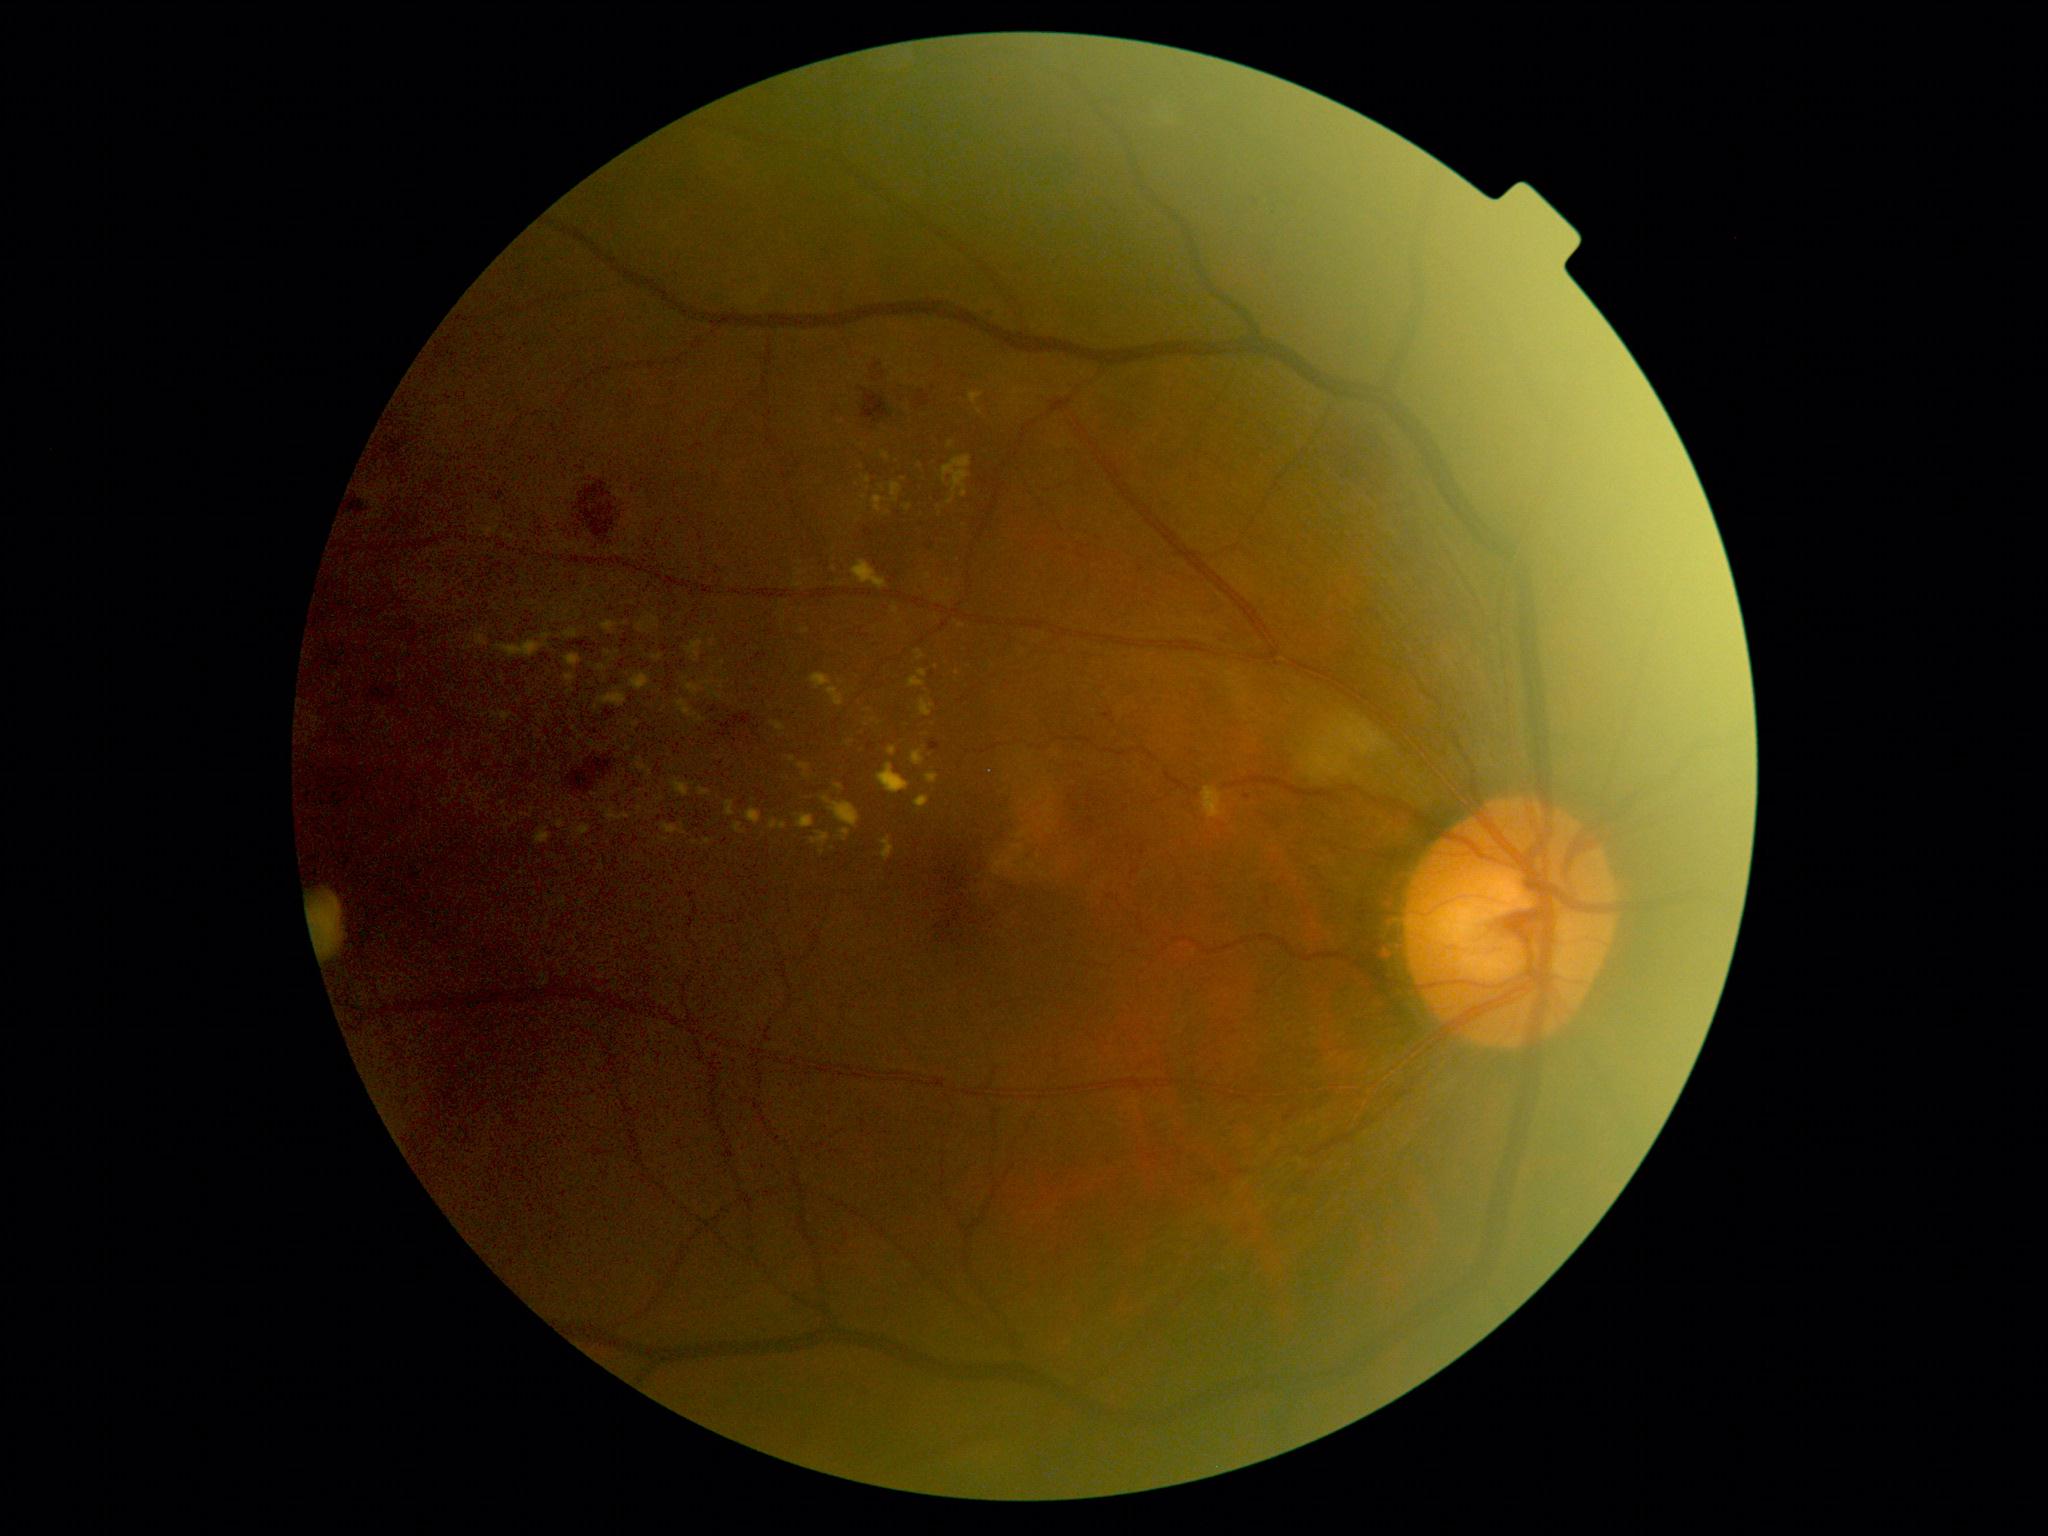 Diabetic retinopathy (DR): moderate non-proliferative diabetic retinopathy (grade 2)
Lesions identified (partial list):
hard exudates (EXs) (continued): l=700, t=789, r=709, b=796; l=477, t=636, r=487, b=646; l=892, t=485, r=900, b=496; l=726, t=802, r=735, b=816; l=638, t=764, r=647, b=770; l=536, t=829, r=550, b=843; l=879, t=764, r=910, b=794; l=910, t=678, r=925, b=688; l=1203, t=787, r=1222, b=819; l=678, t=701, r=691, b=715; l=673, t=781, r=689, b=797
Additional small EXs near [x=602, y=668]; [x=708, y=842]; [x=495, y=716]; [x=793, y=759]; [x=560, y=825]